2212 by 1659 pixels. Color fundus photograph:
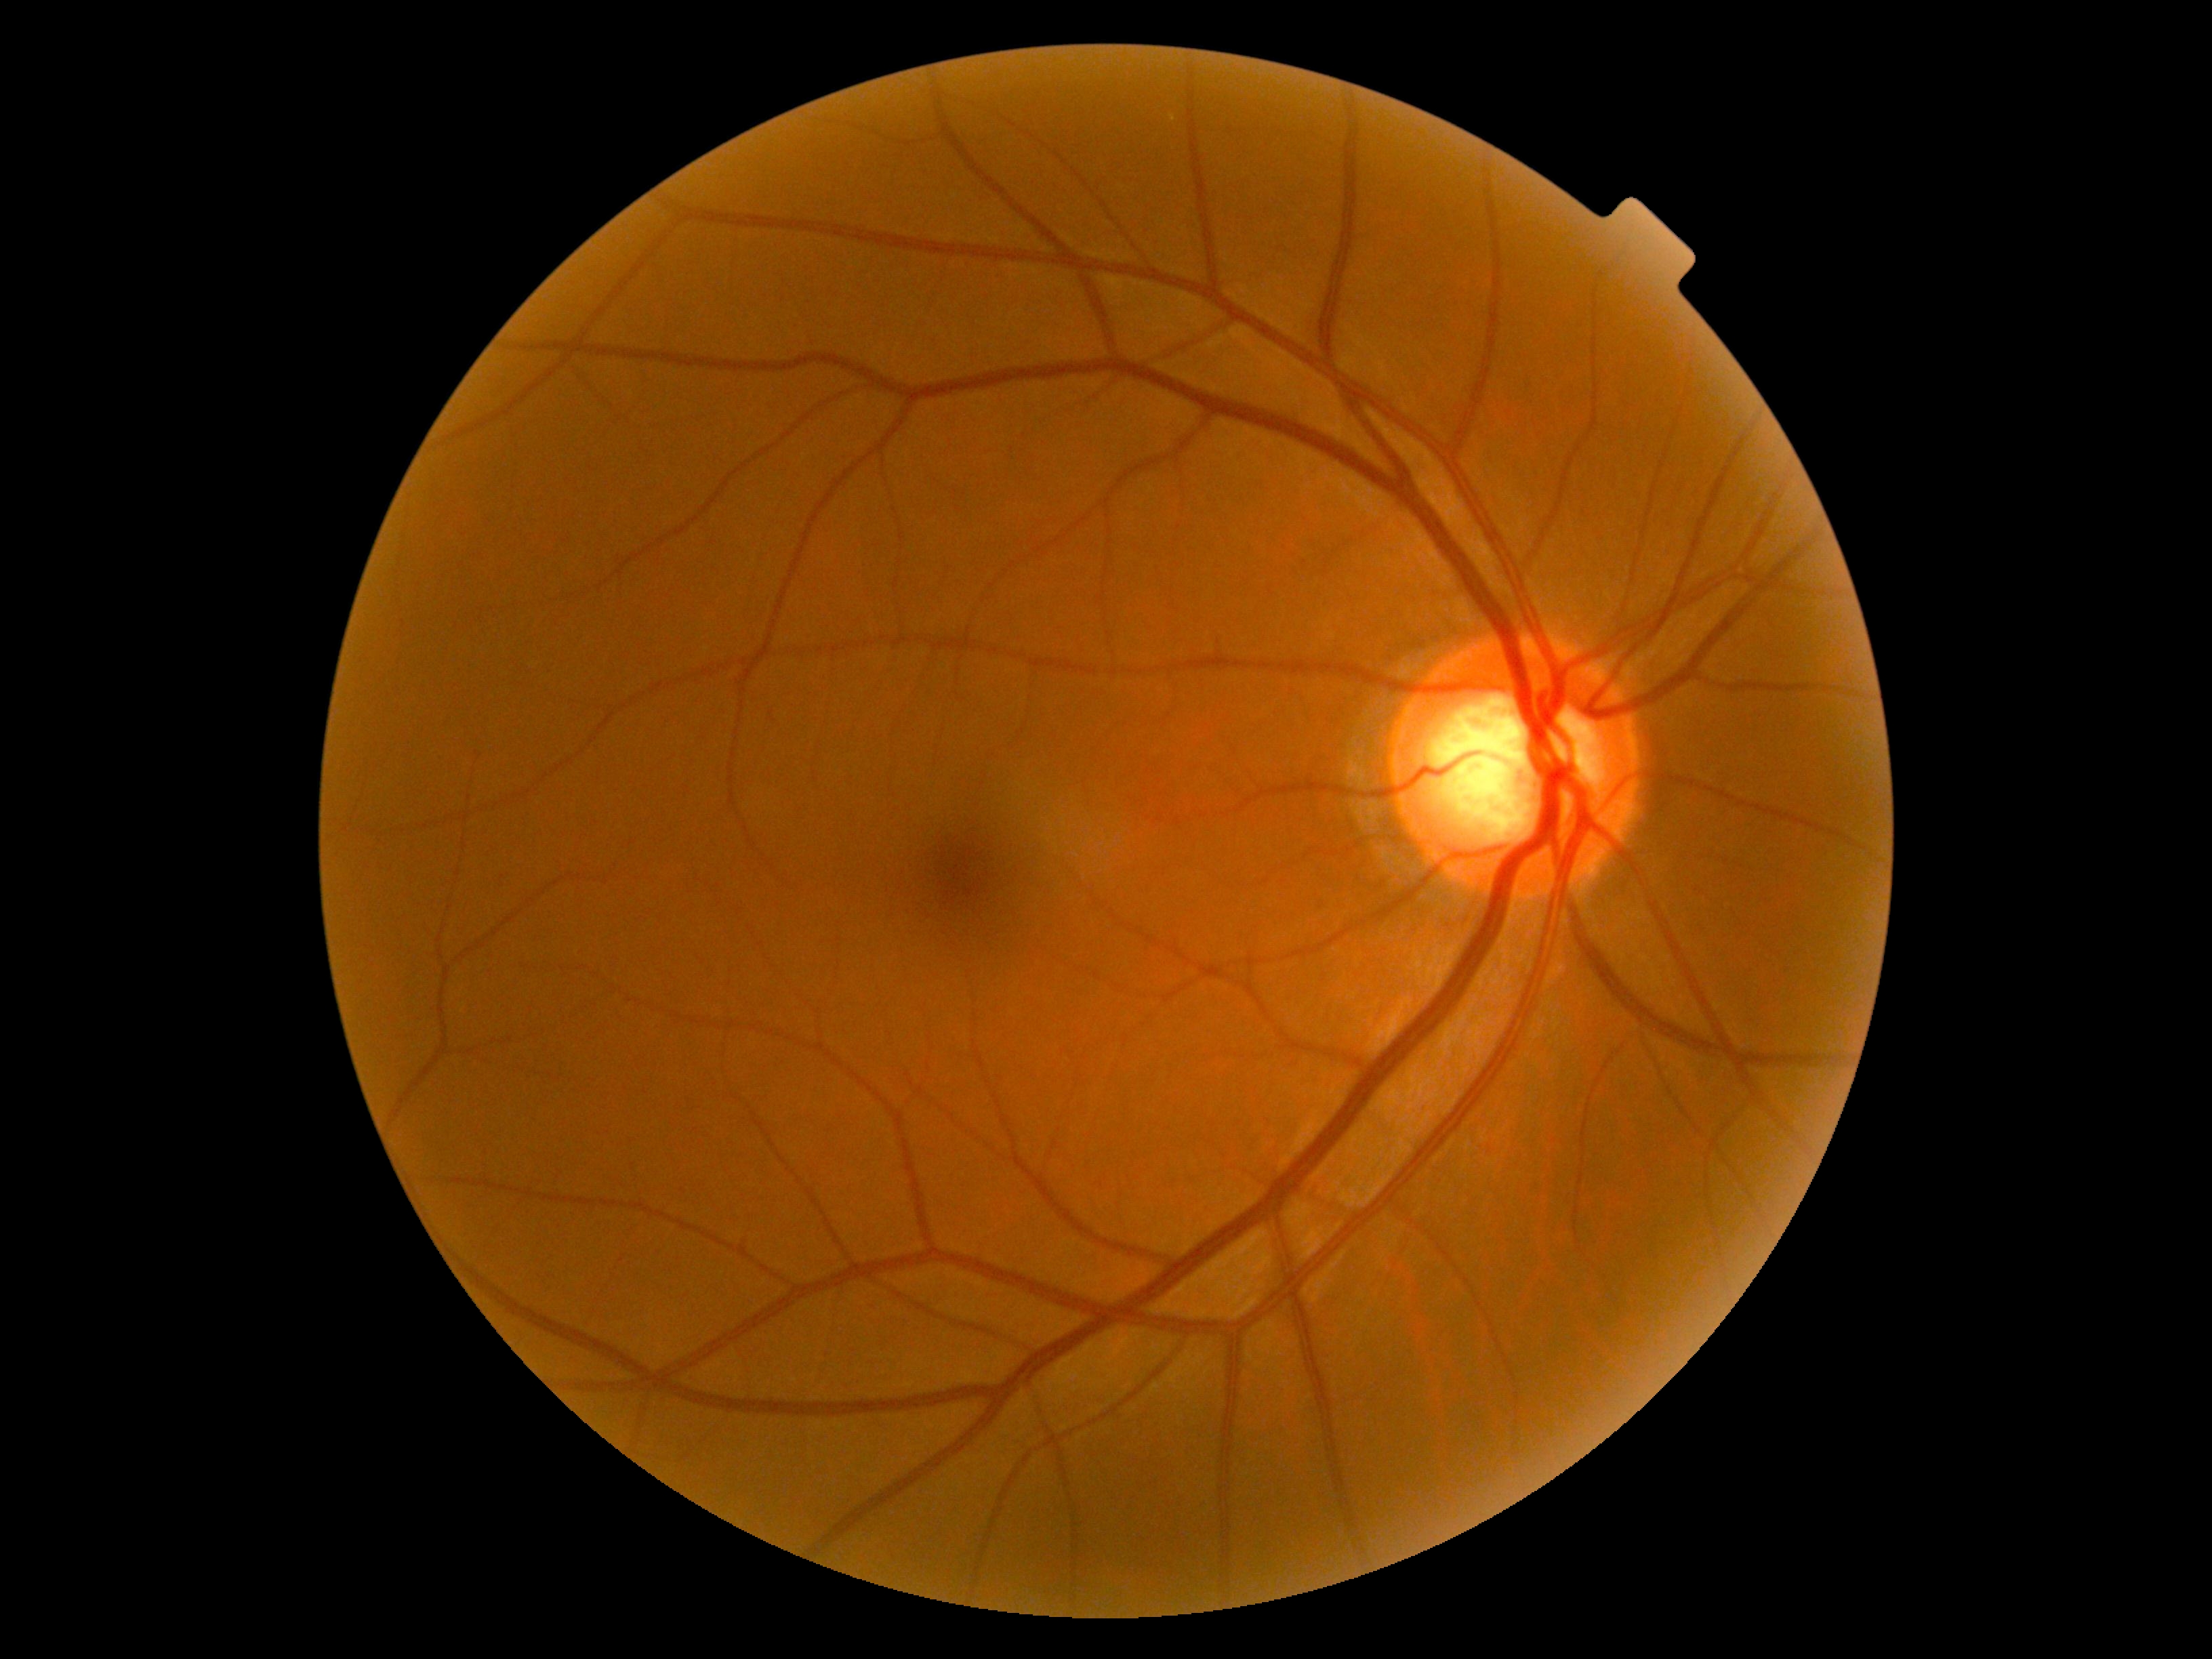
DR severity: 0/4.